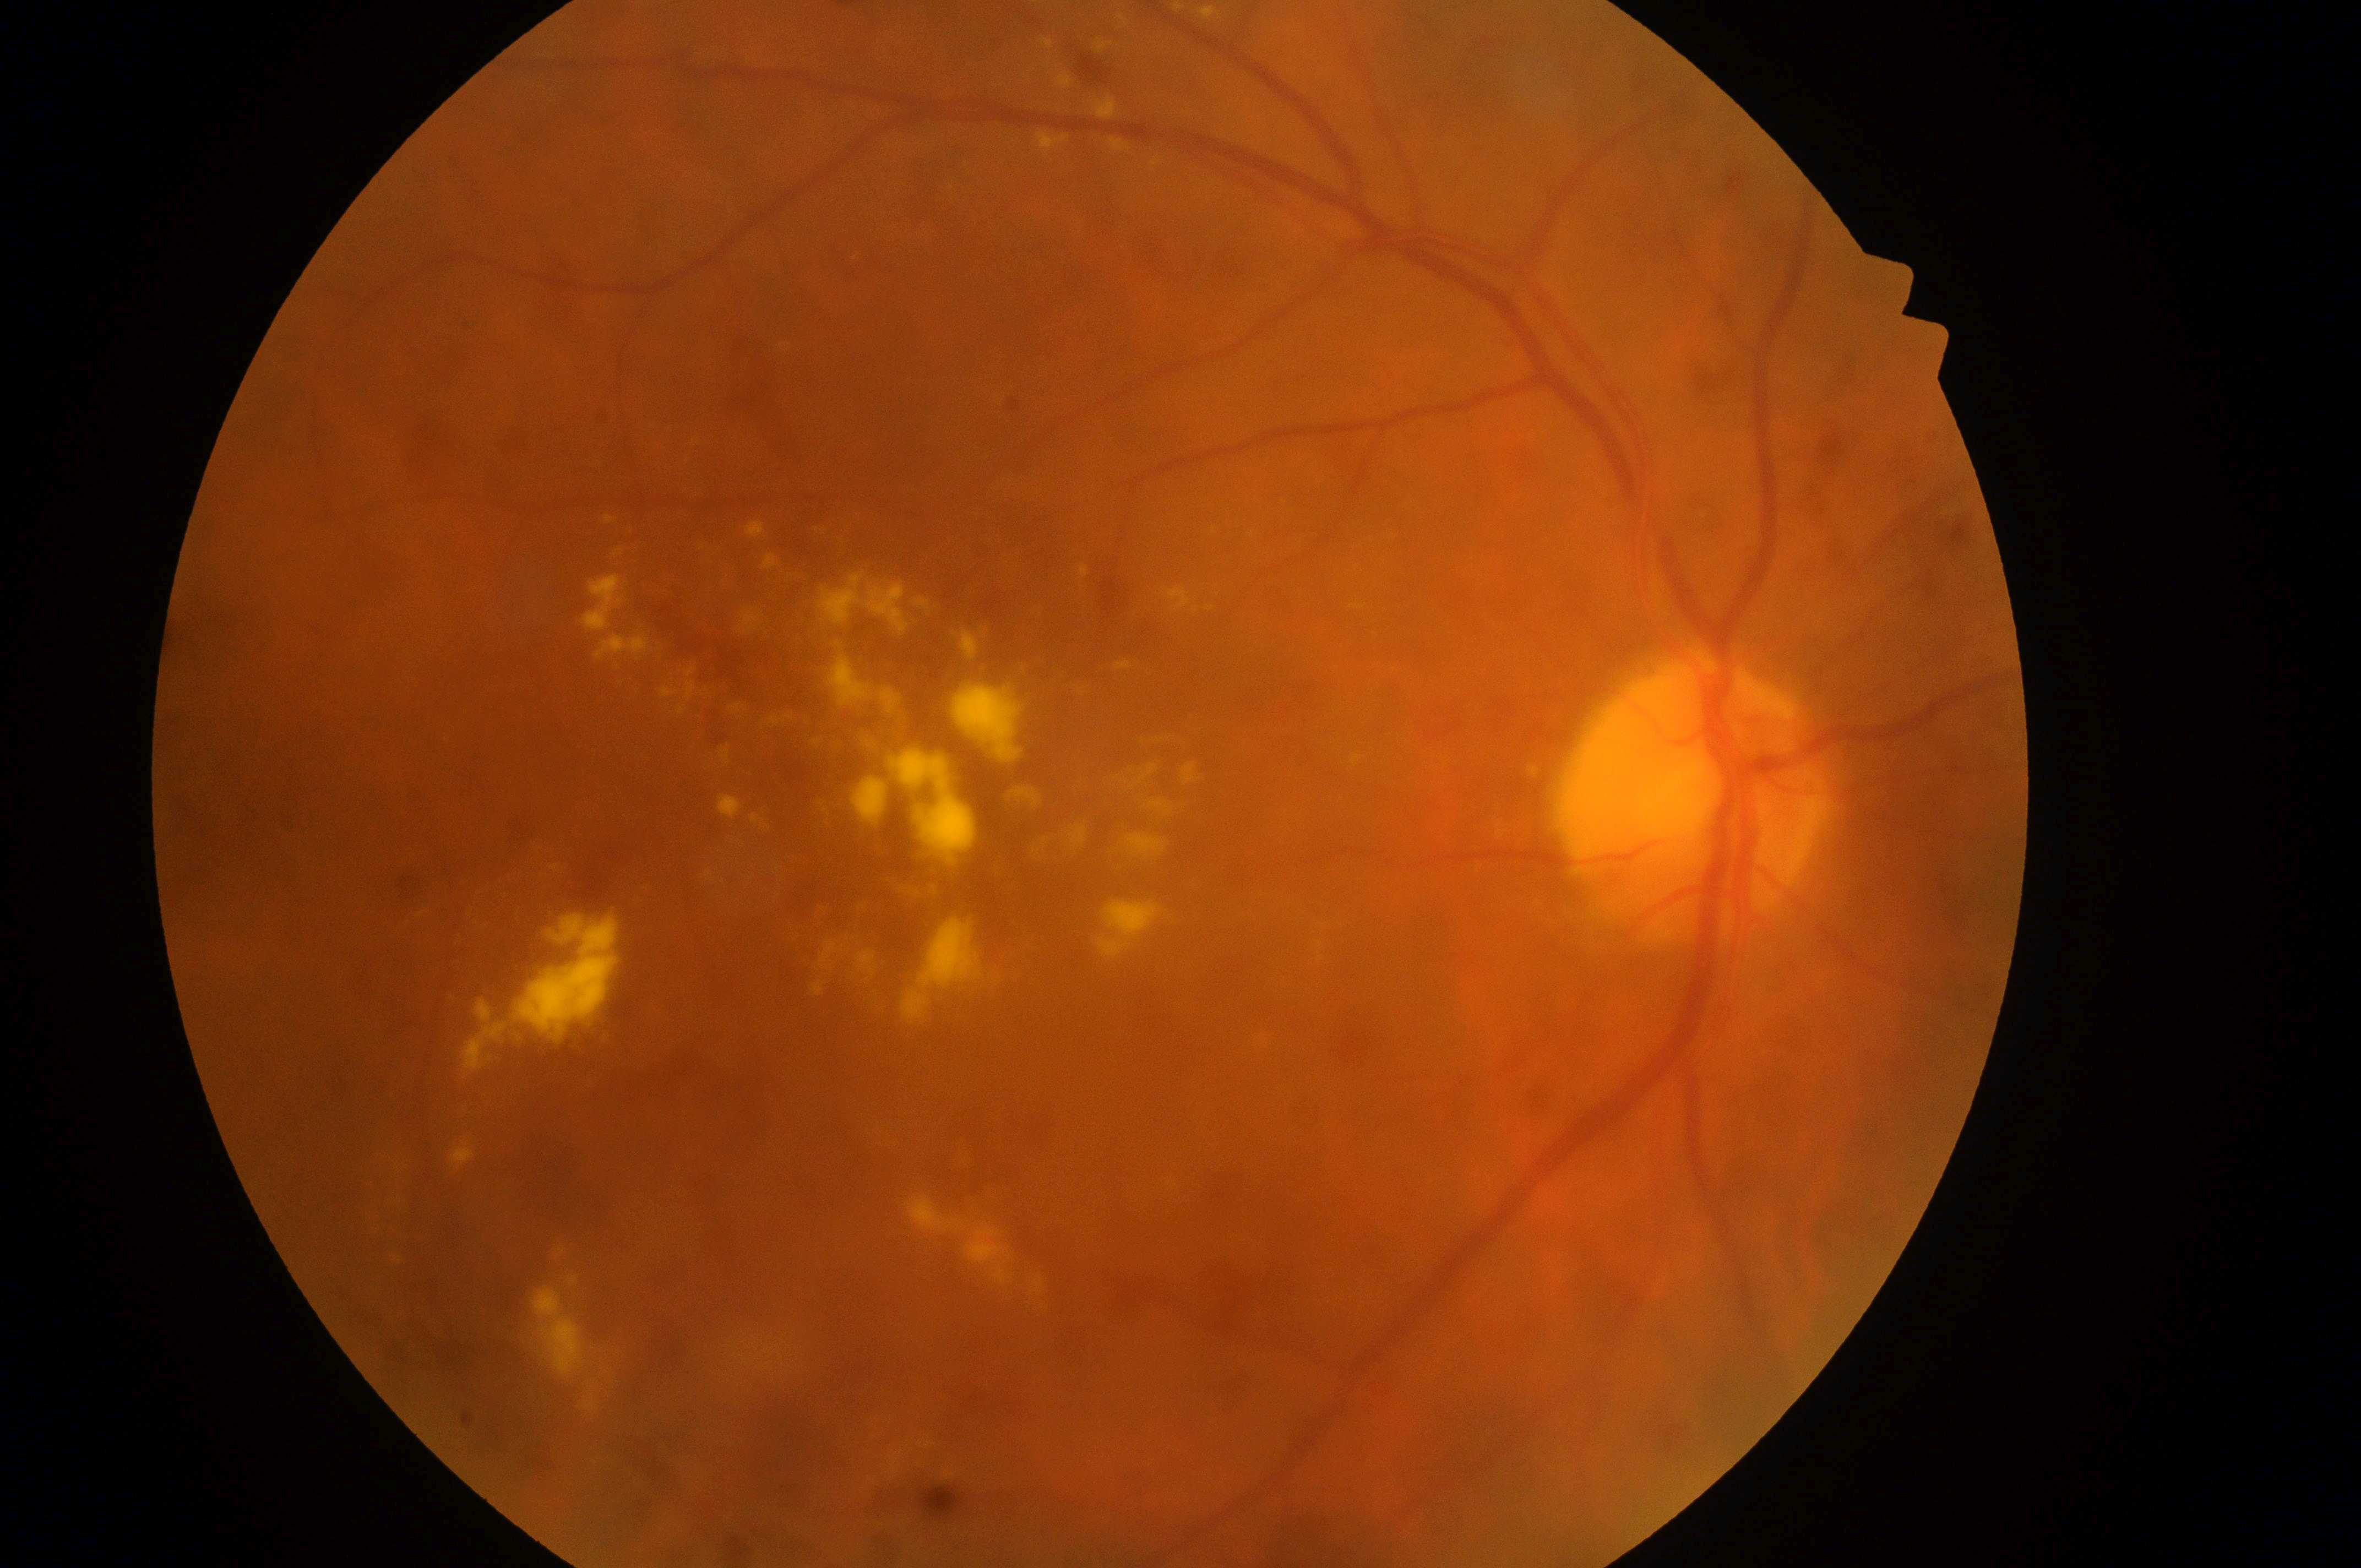
Fovea centralis located at 1076, 868.
Retinopathy is grade 2 (moderate NPDR) — more than just microaneurysms but less than severe NPDR.
The optic disk is at 1694, 816.
Eye: right eye.
Diabetic macular edema: high risk (grade 2) — hard exudates within one disc diameter of the macula center.